Camera: Nidek AFC-330 — 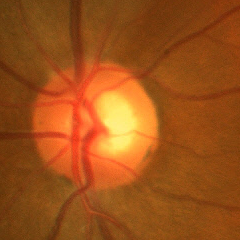

Impression = early glaucoma.